Color fundus image · 2346x1568px — 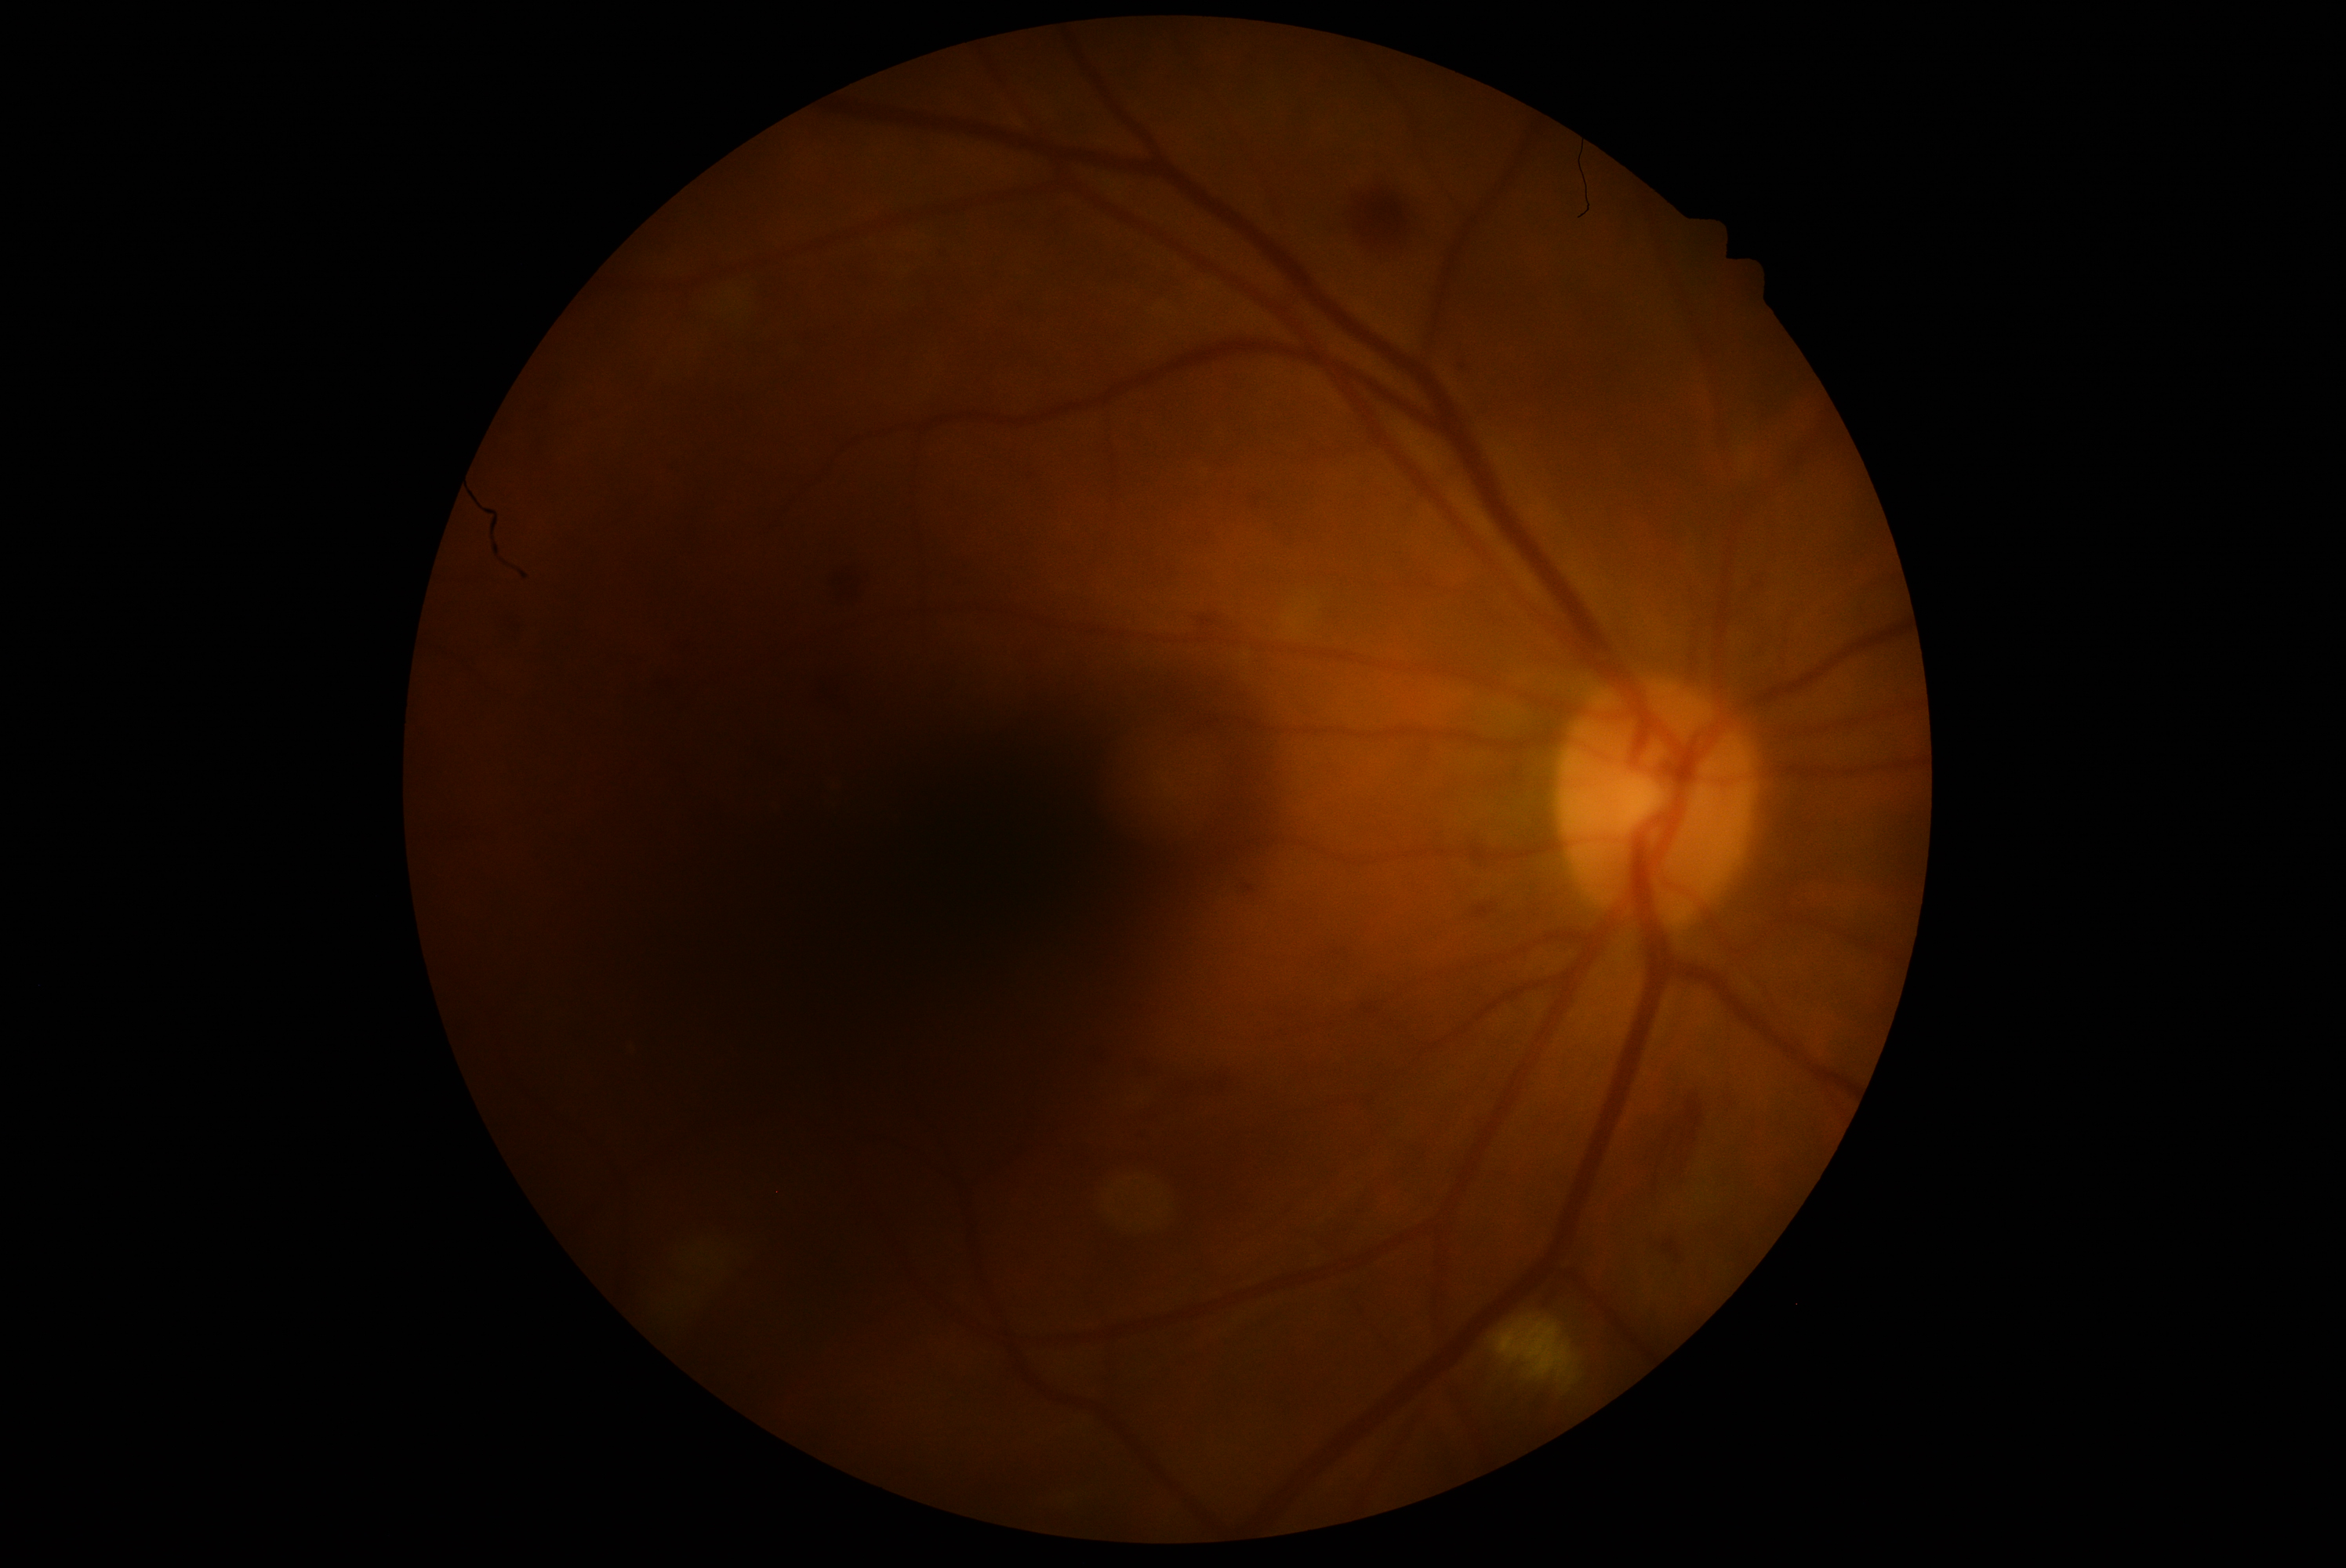 diabetic retinopathy (DR) = moderate NPDR (grade 2) — more than just microaneurysms but less than severe NPDR